Macula-centered. Captured after pupil dilation.
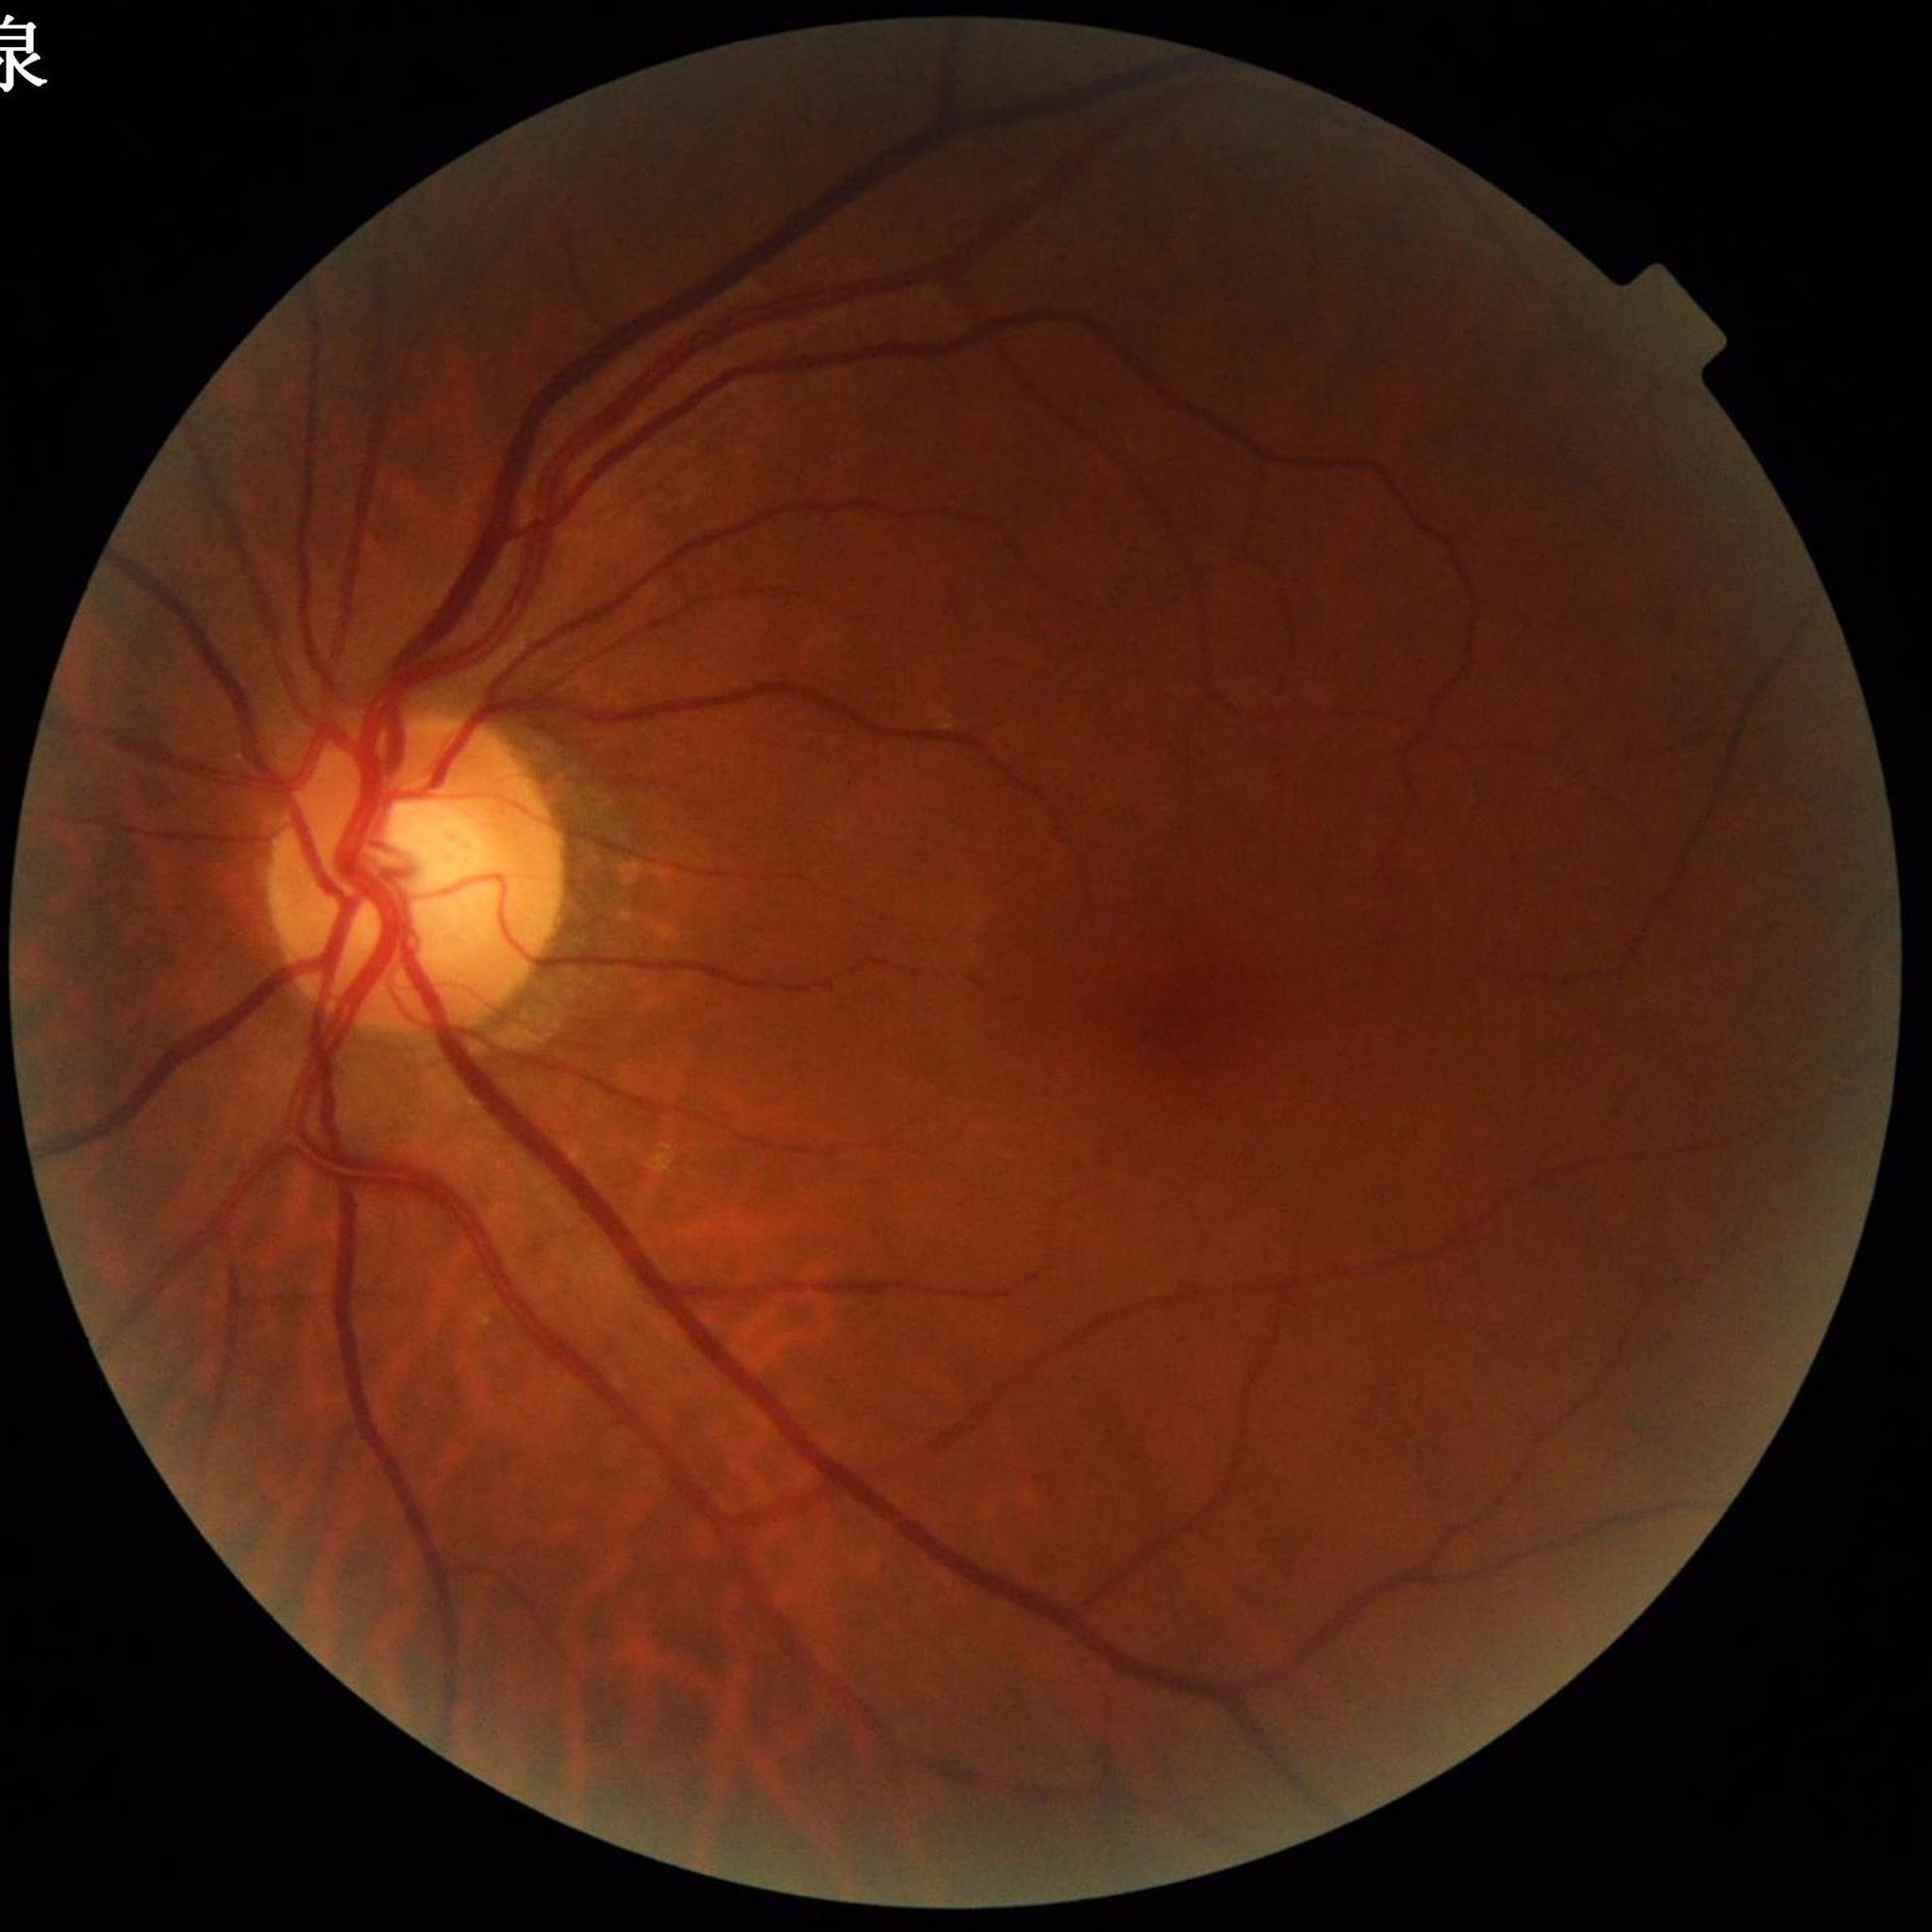

Impression: glaucoma | Automated quality assessment: no concerns identified.